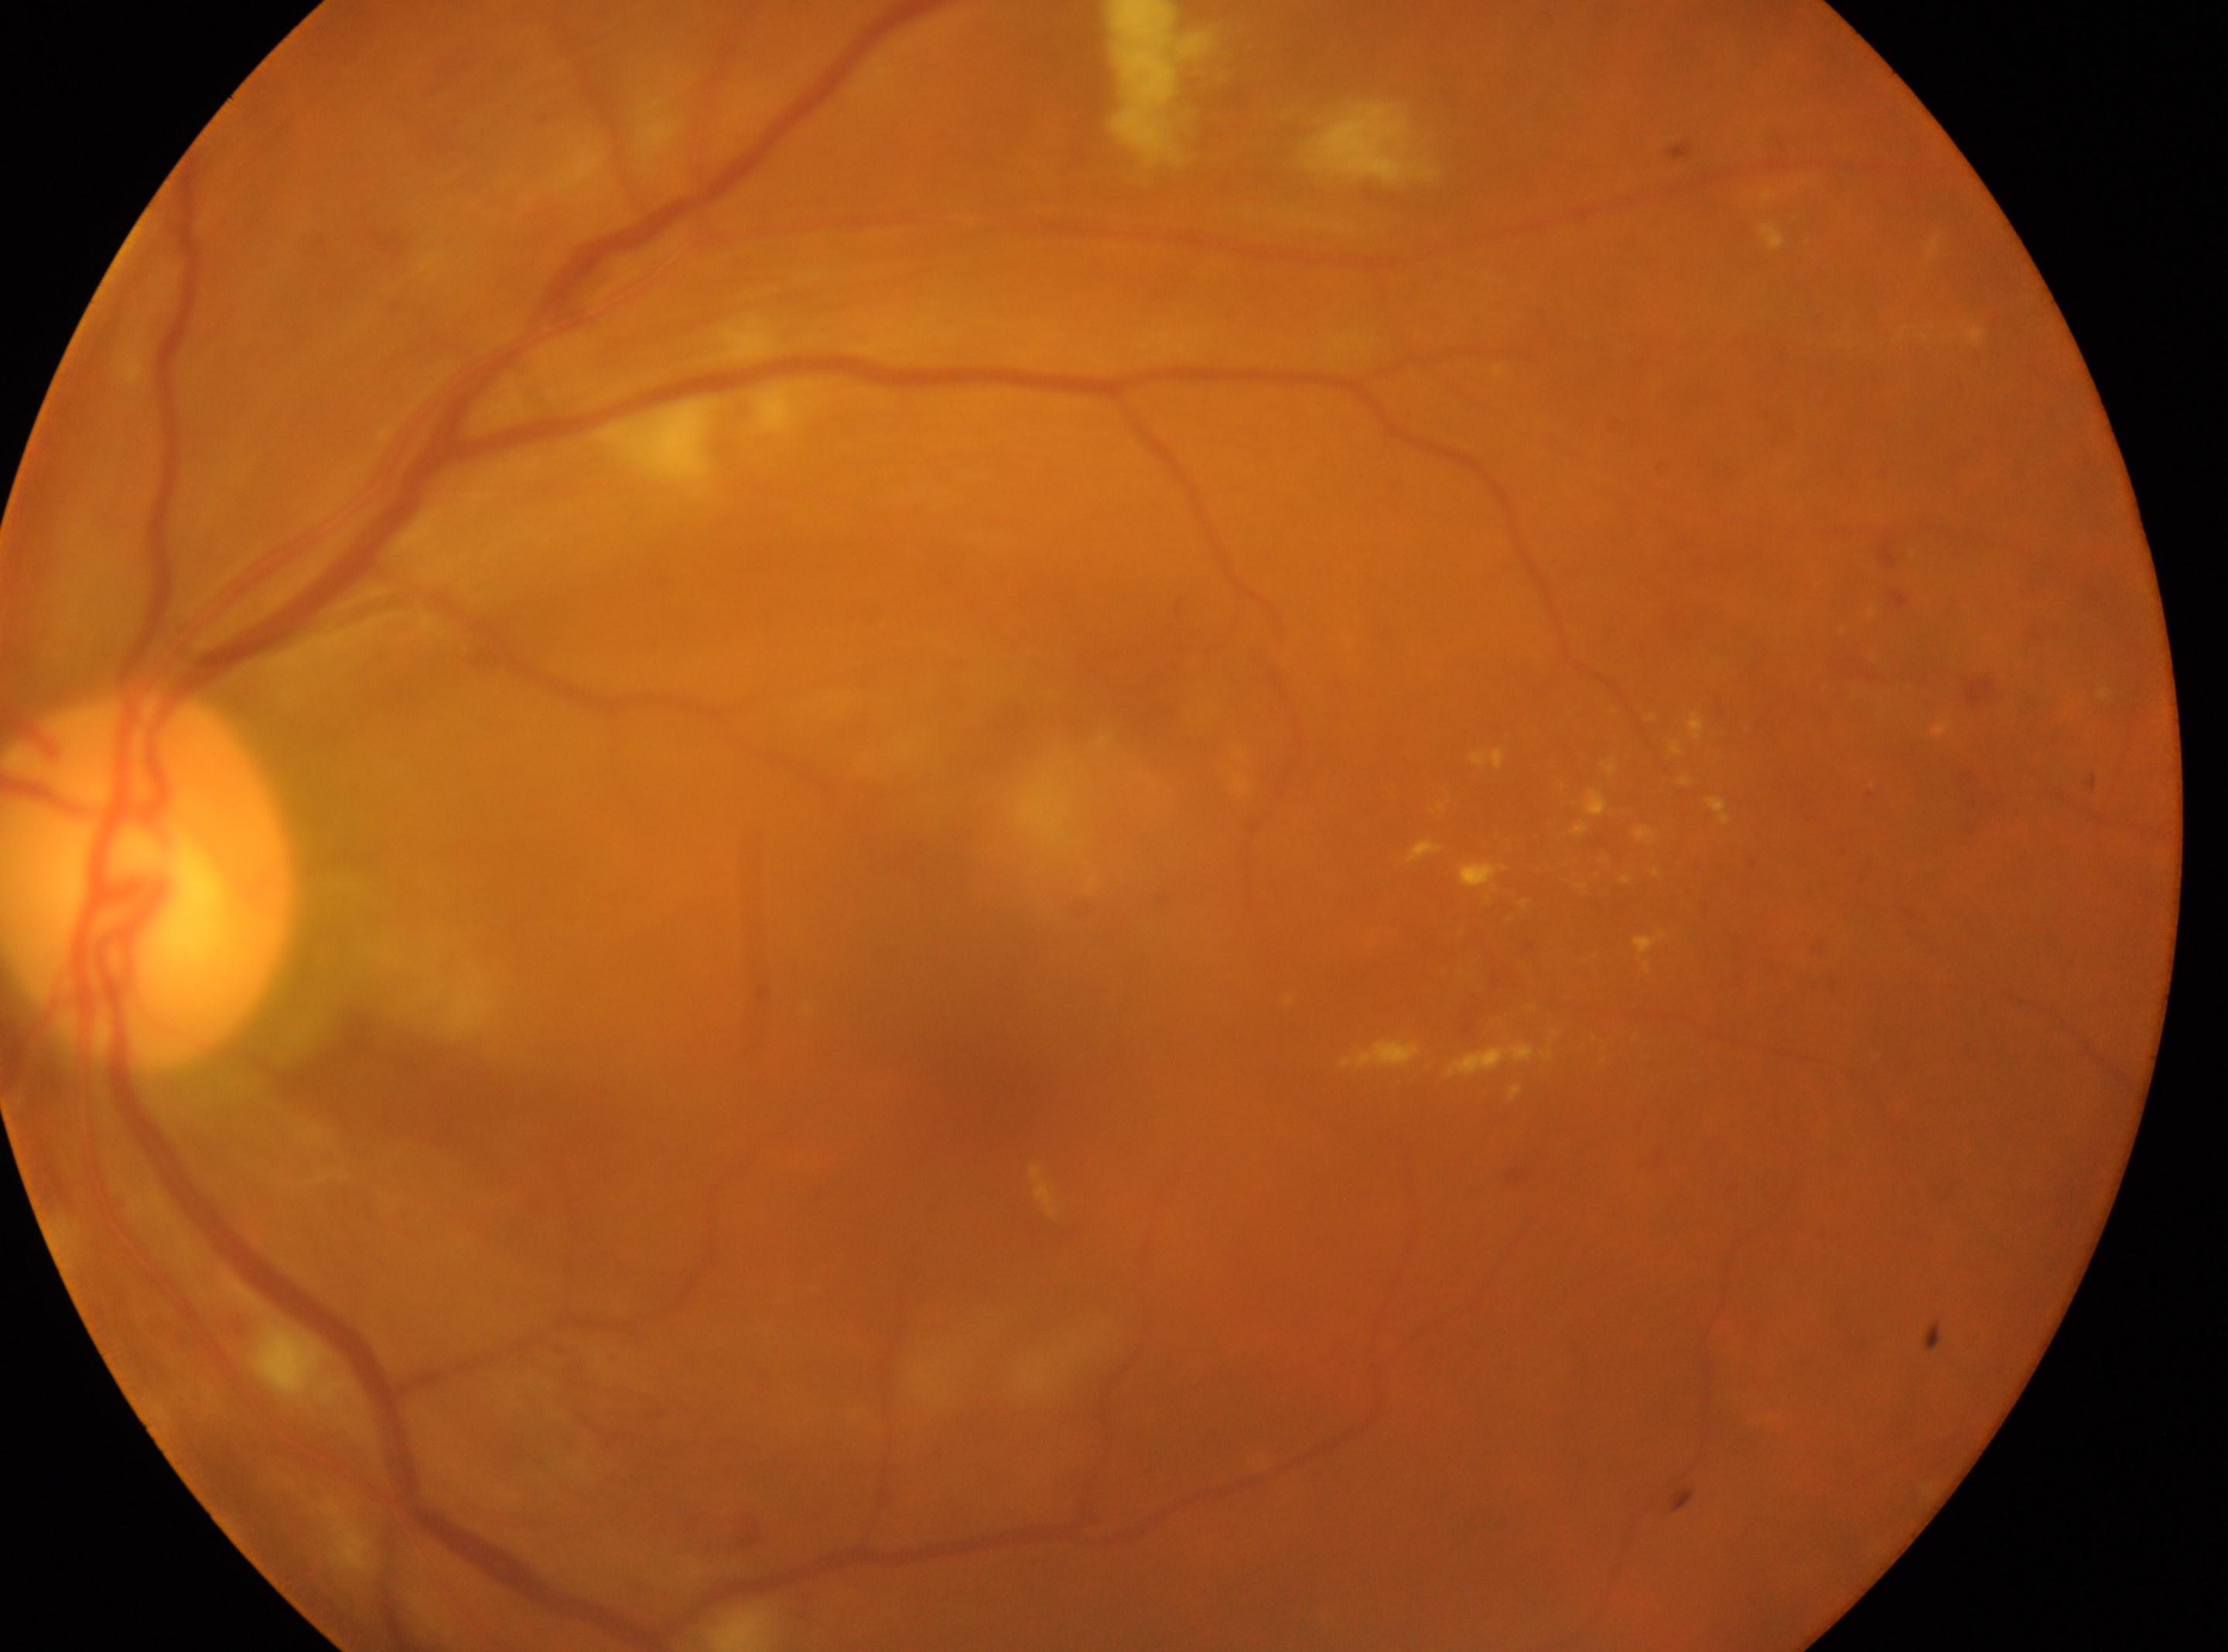

Optic disc located at (x: 147, y: 878).
This is the OS.
Diabetic retinopathy (DR): 2.
The fovea is at (x: 982, y: 1064).